1240 by 1240 pixels · camera: Phoenix ICON (100° FOV) · pediatric retinal photograph (wide-field) — 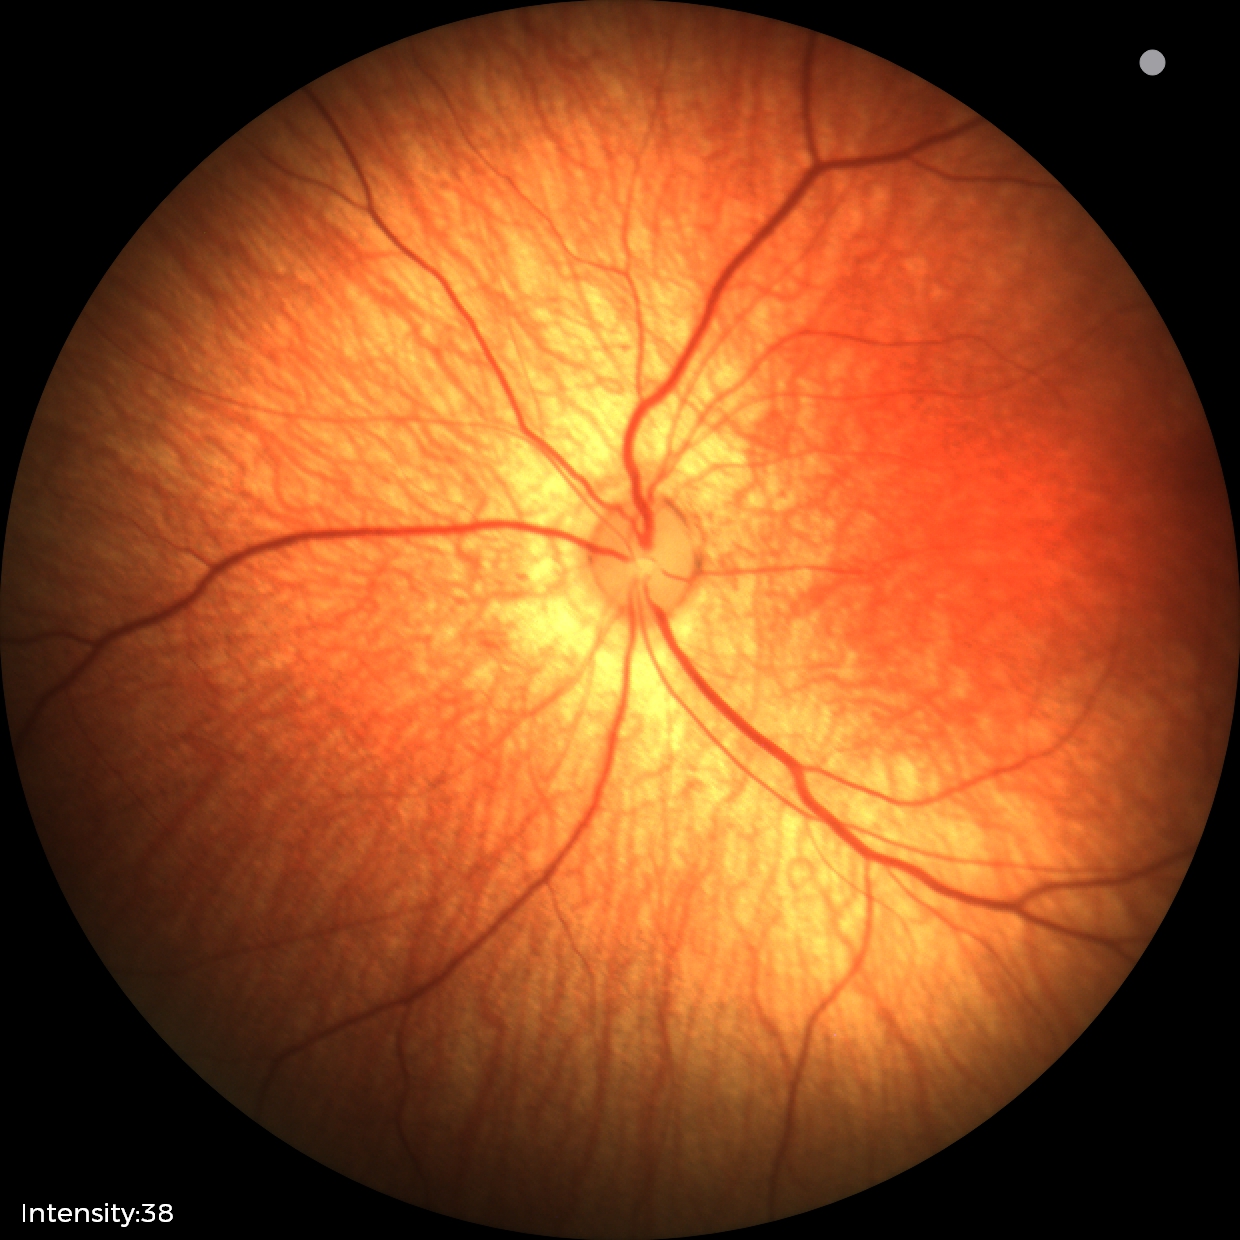

Screening examination with no abnormal retinal findings.